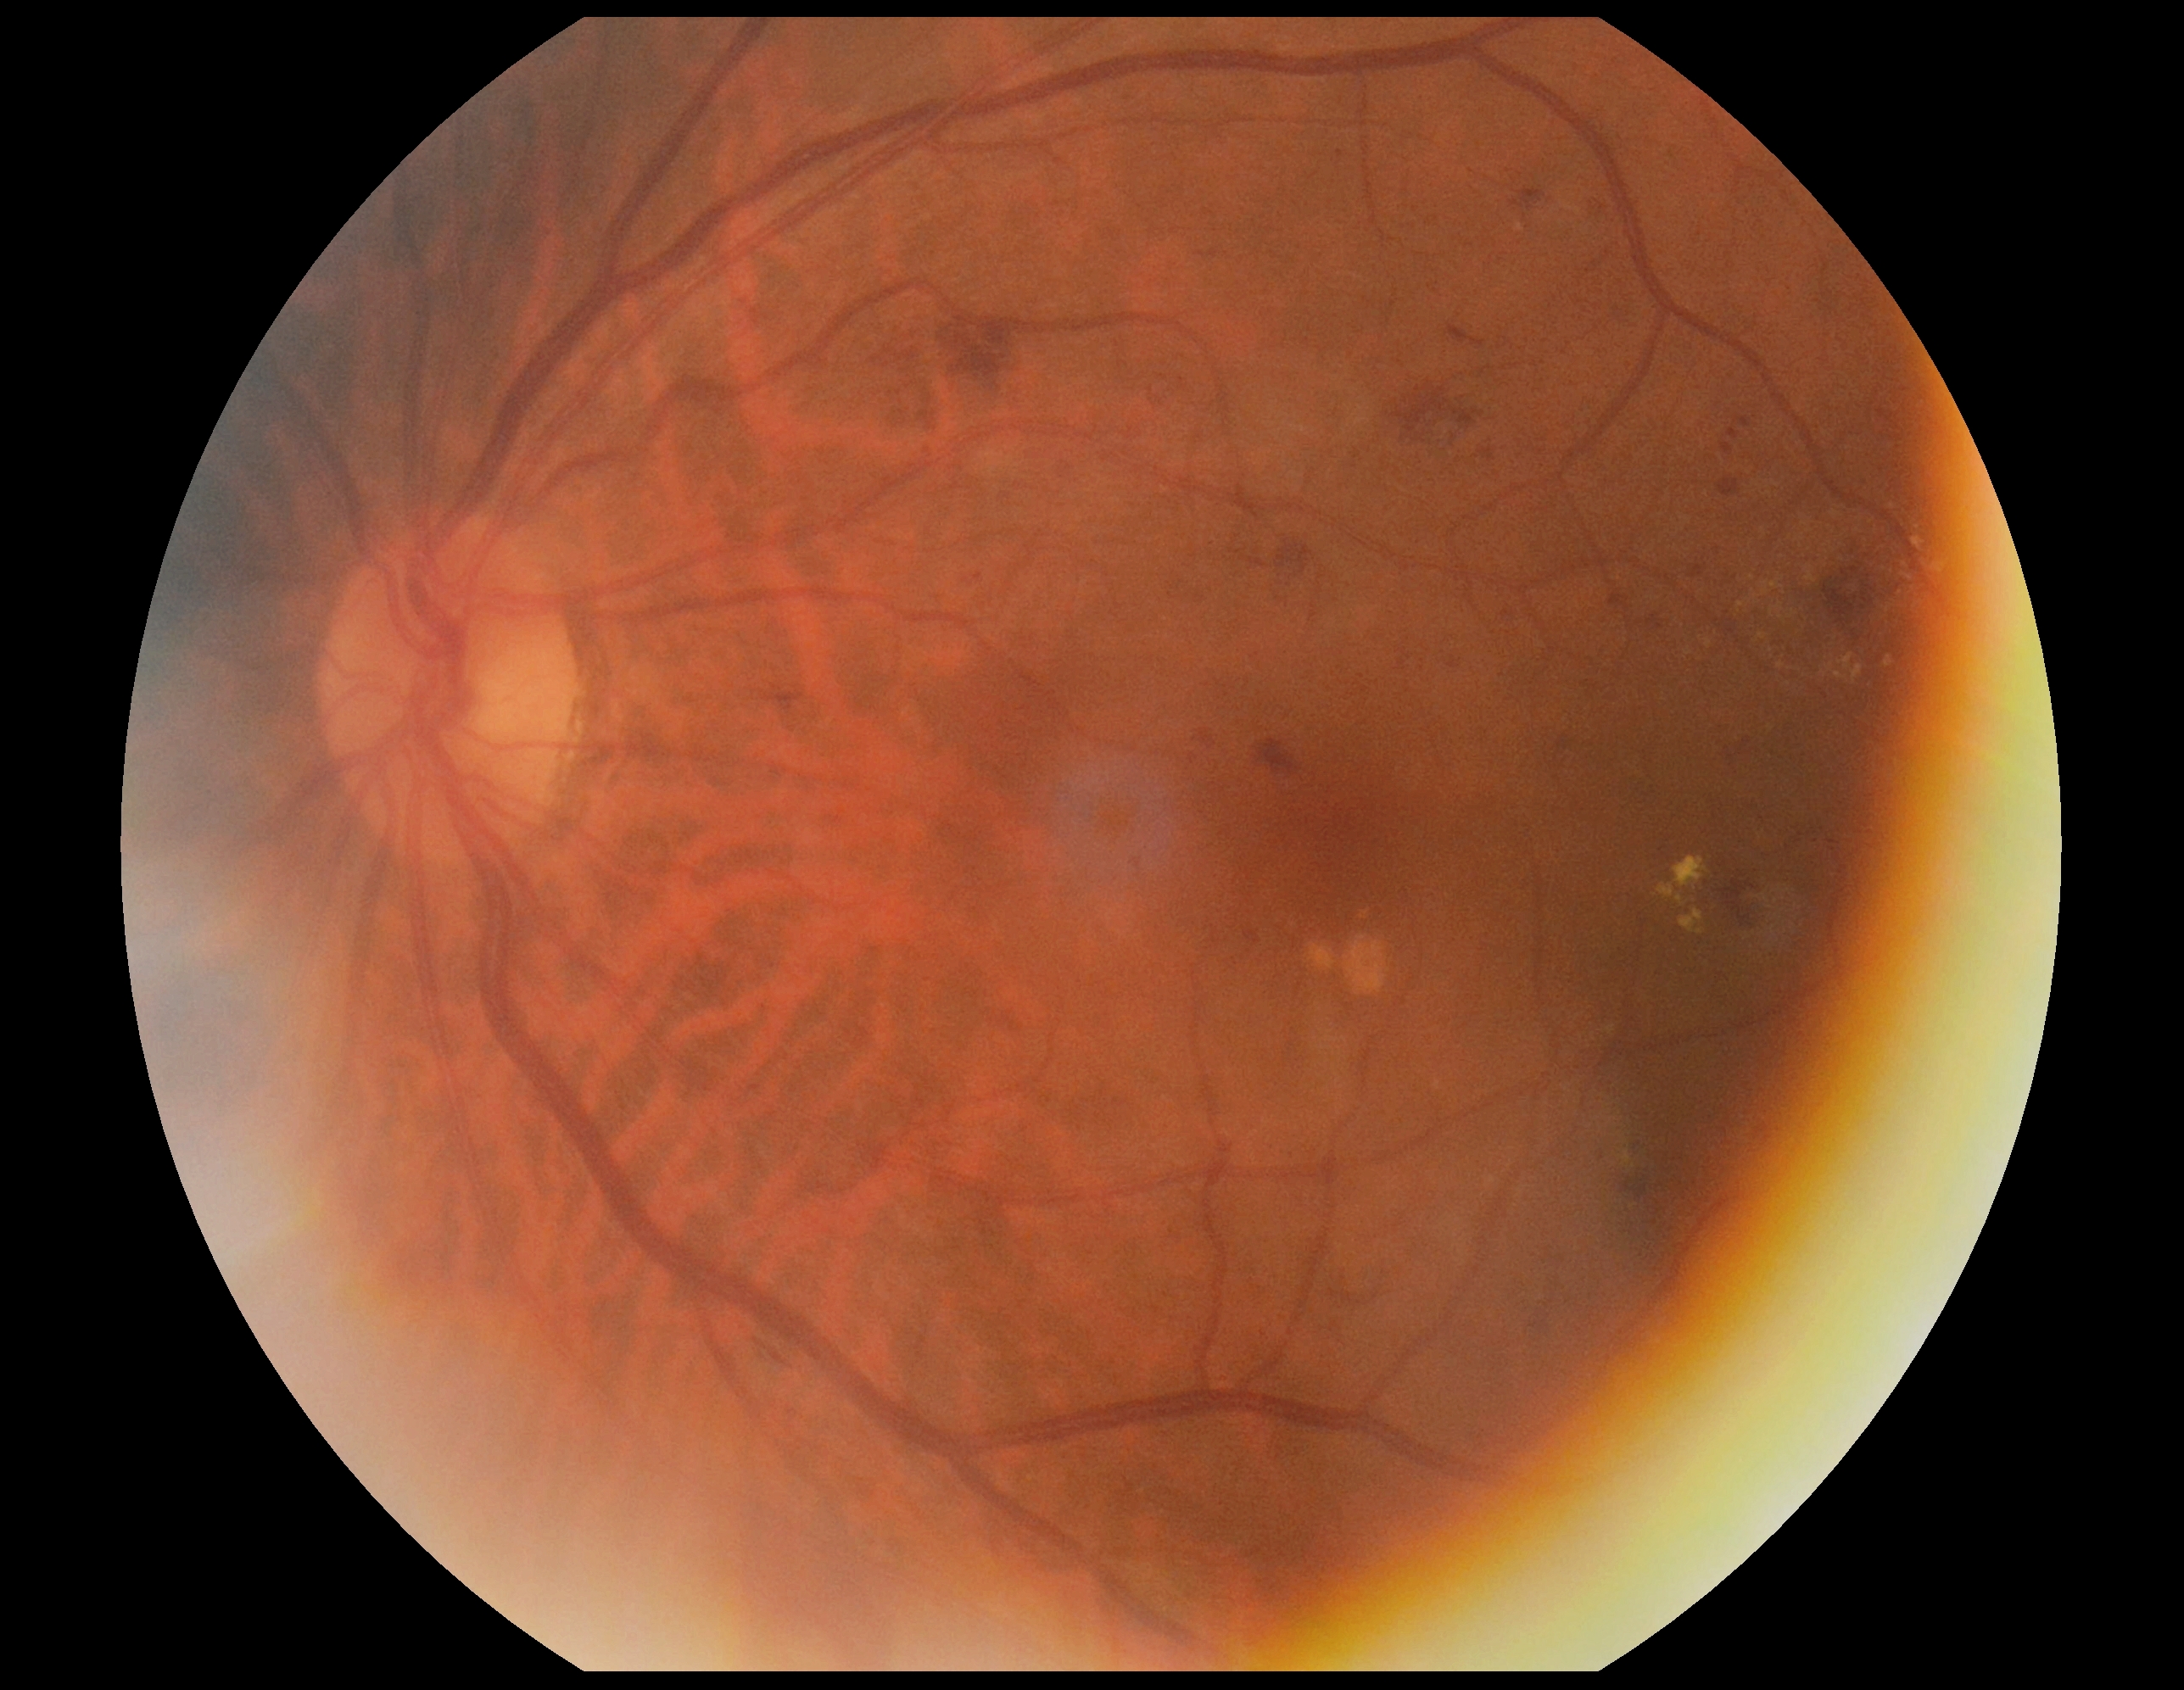

DR severity = grade 2.